Color fundus image. 2212x1659px
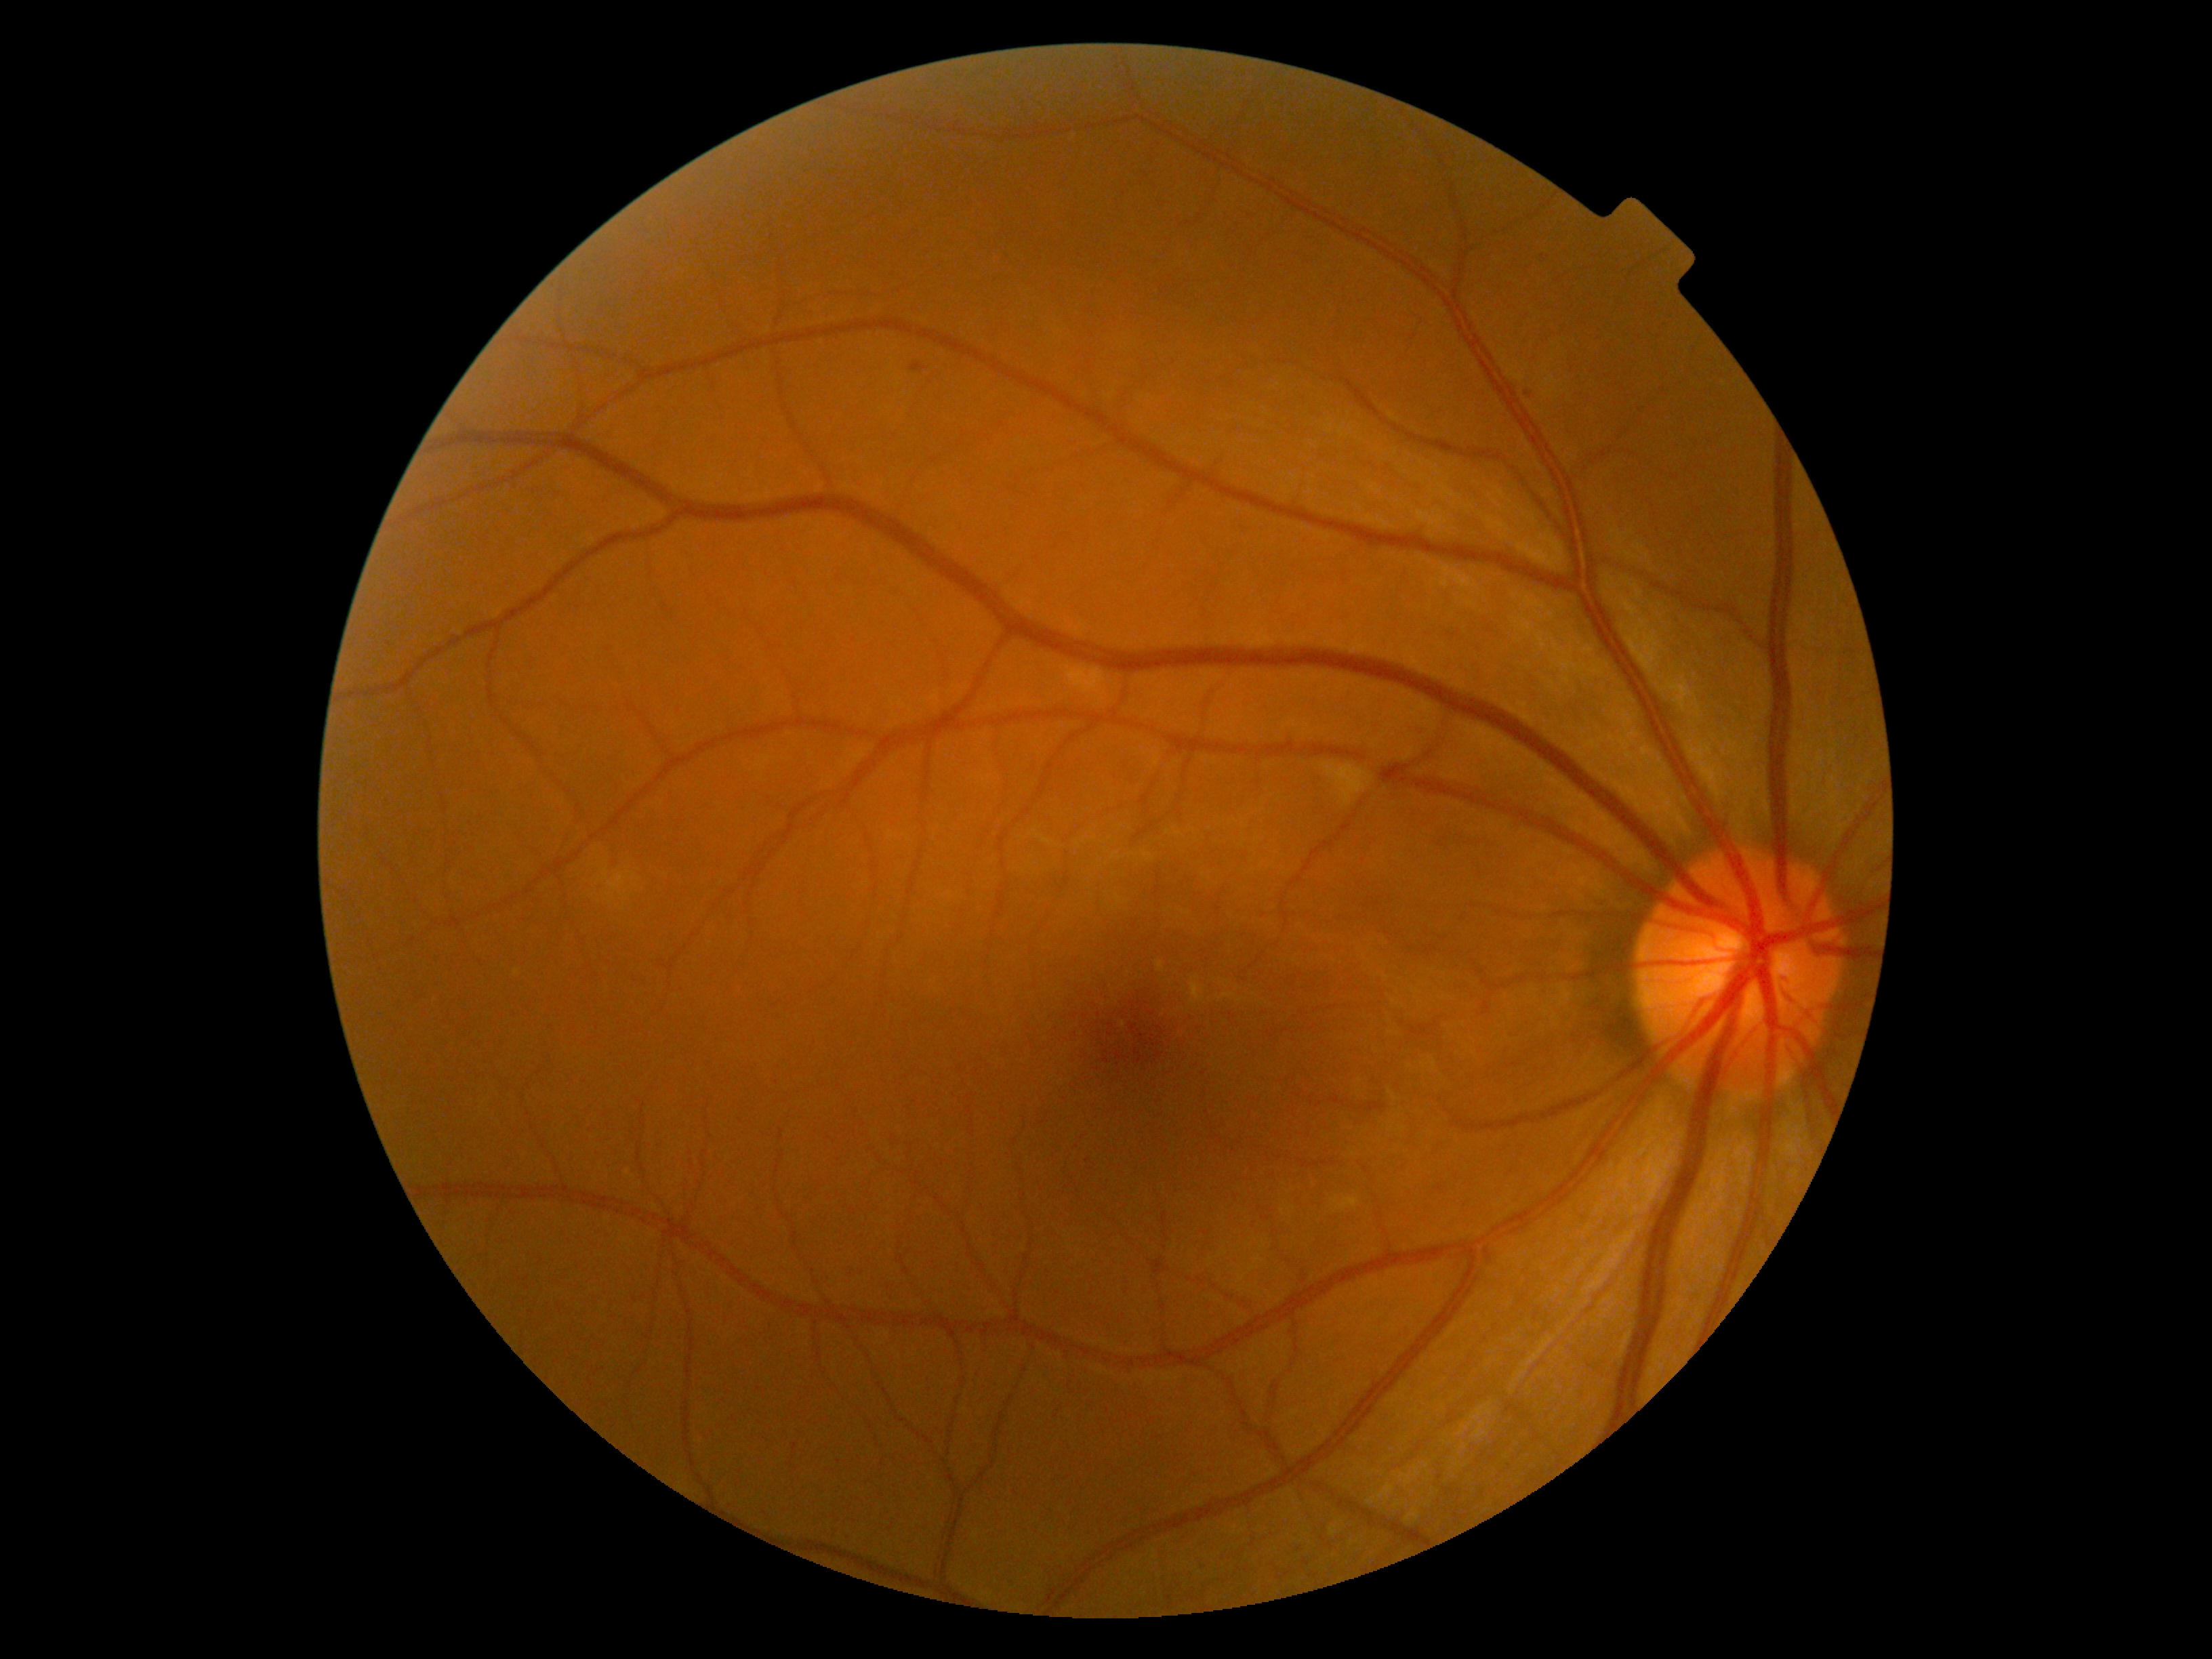
diabetic retinopathy (DR): grade 2 (moderate NPDR) — more than just microaneurysms but less than severe NPDR.